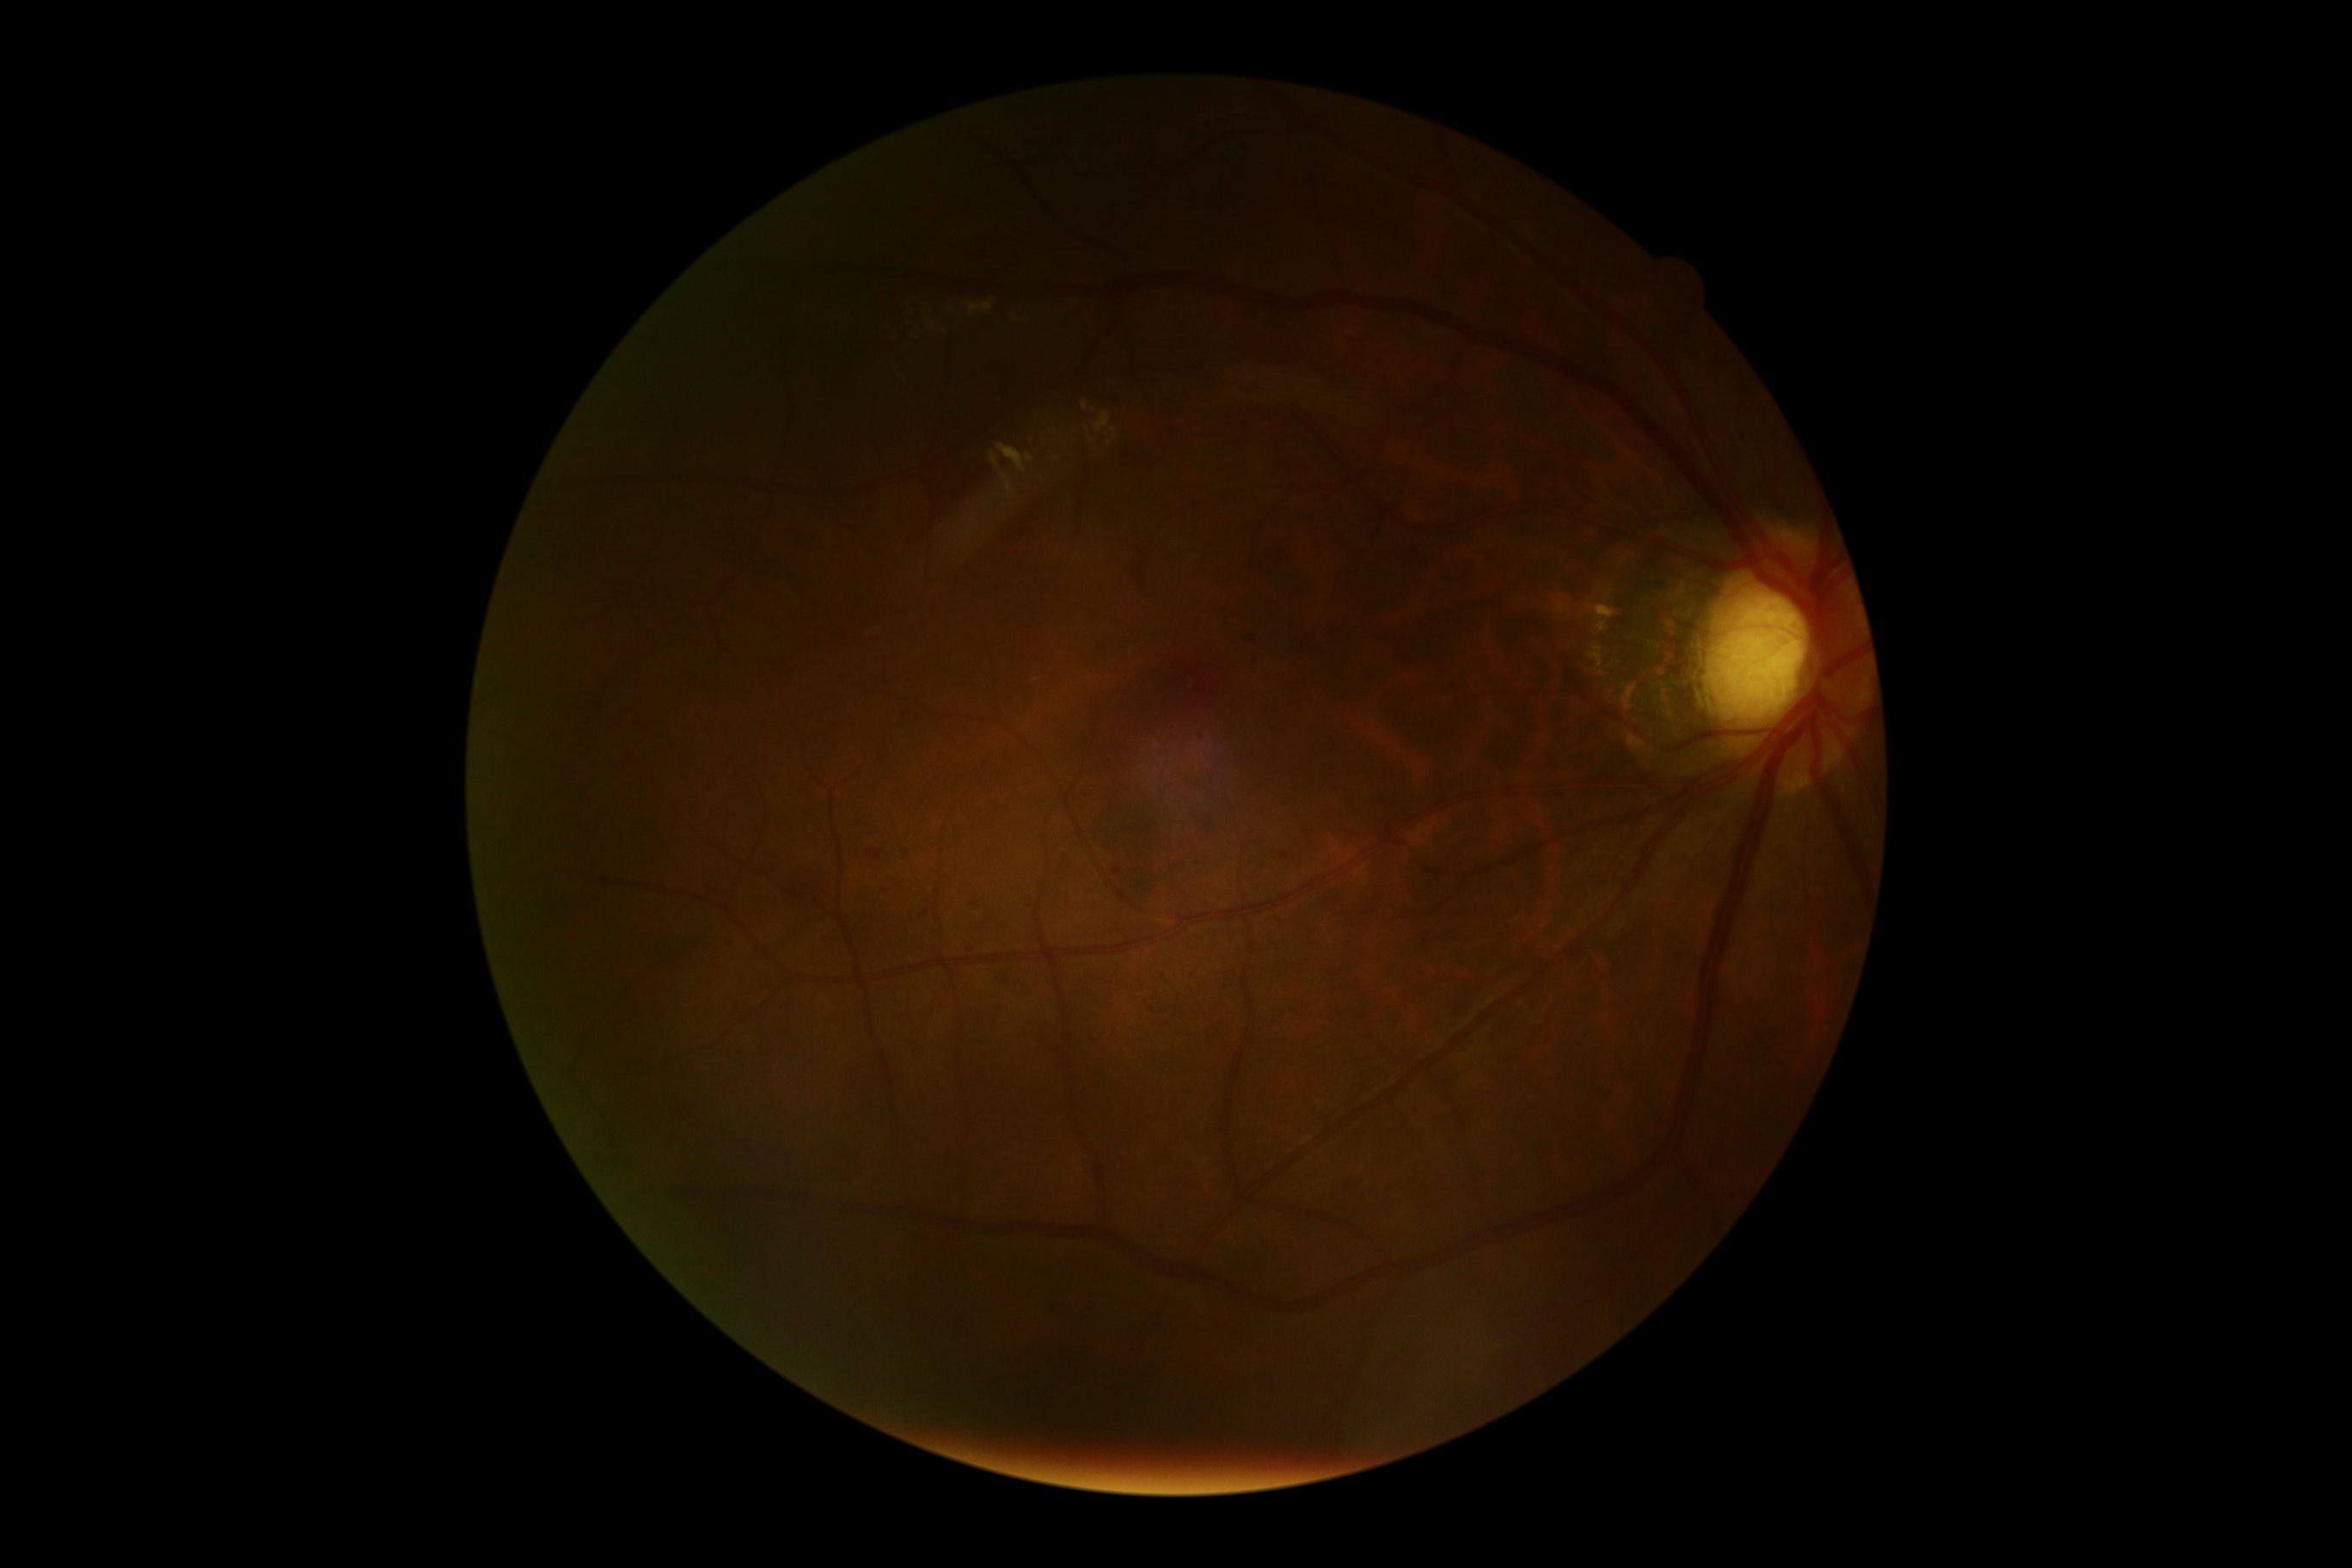

The retinopathy is classified as non-proliferative diabetic retinopathy.
DR: moderate non-proliferative diabetic retinopathy (grade 2).